2102x1736 — 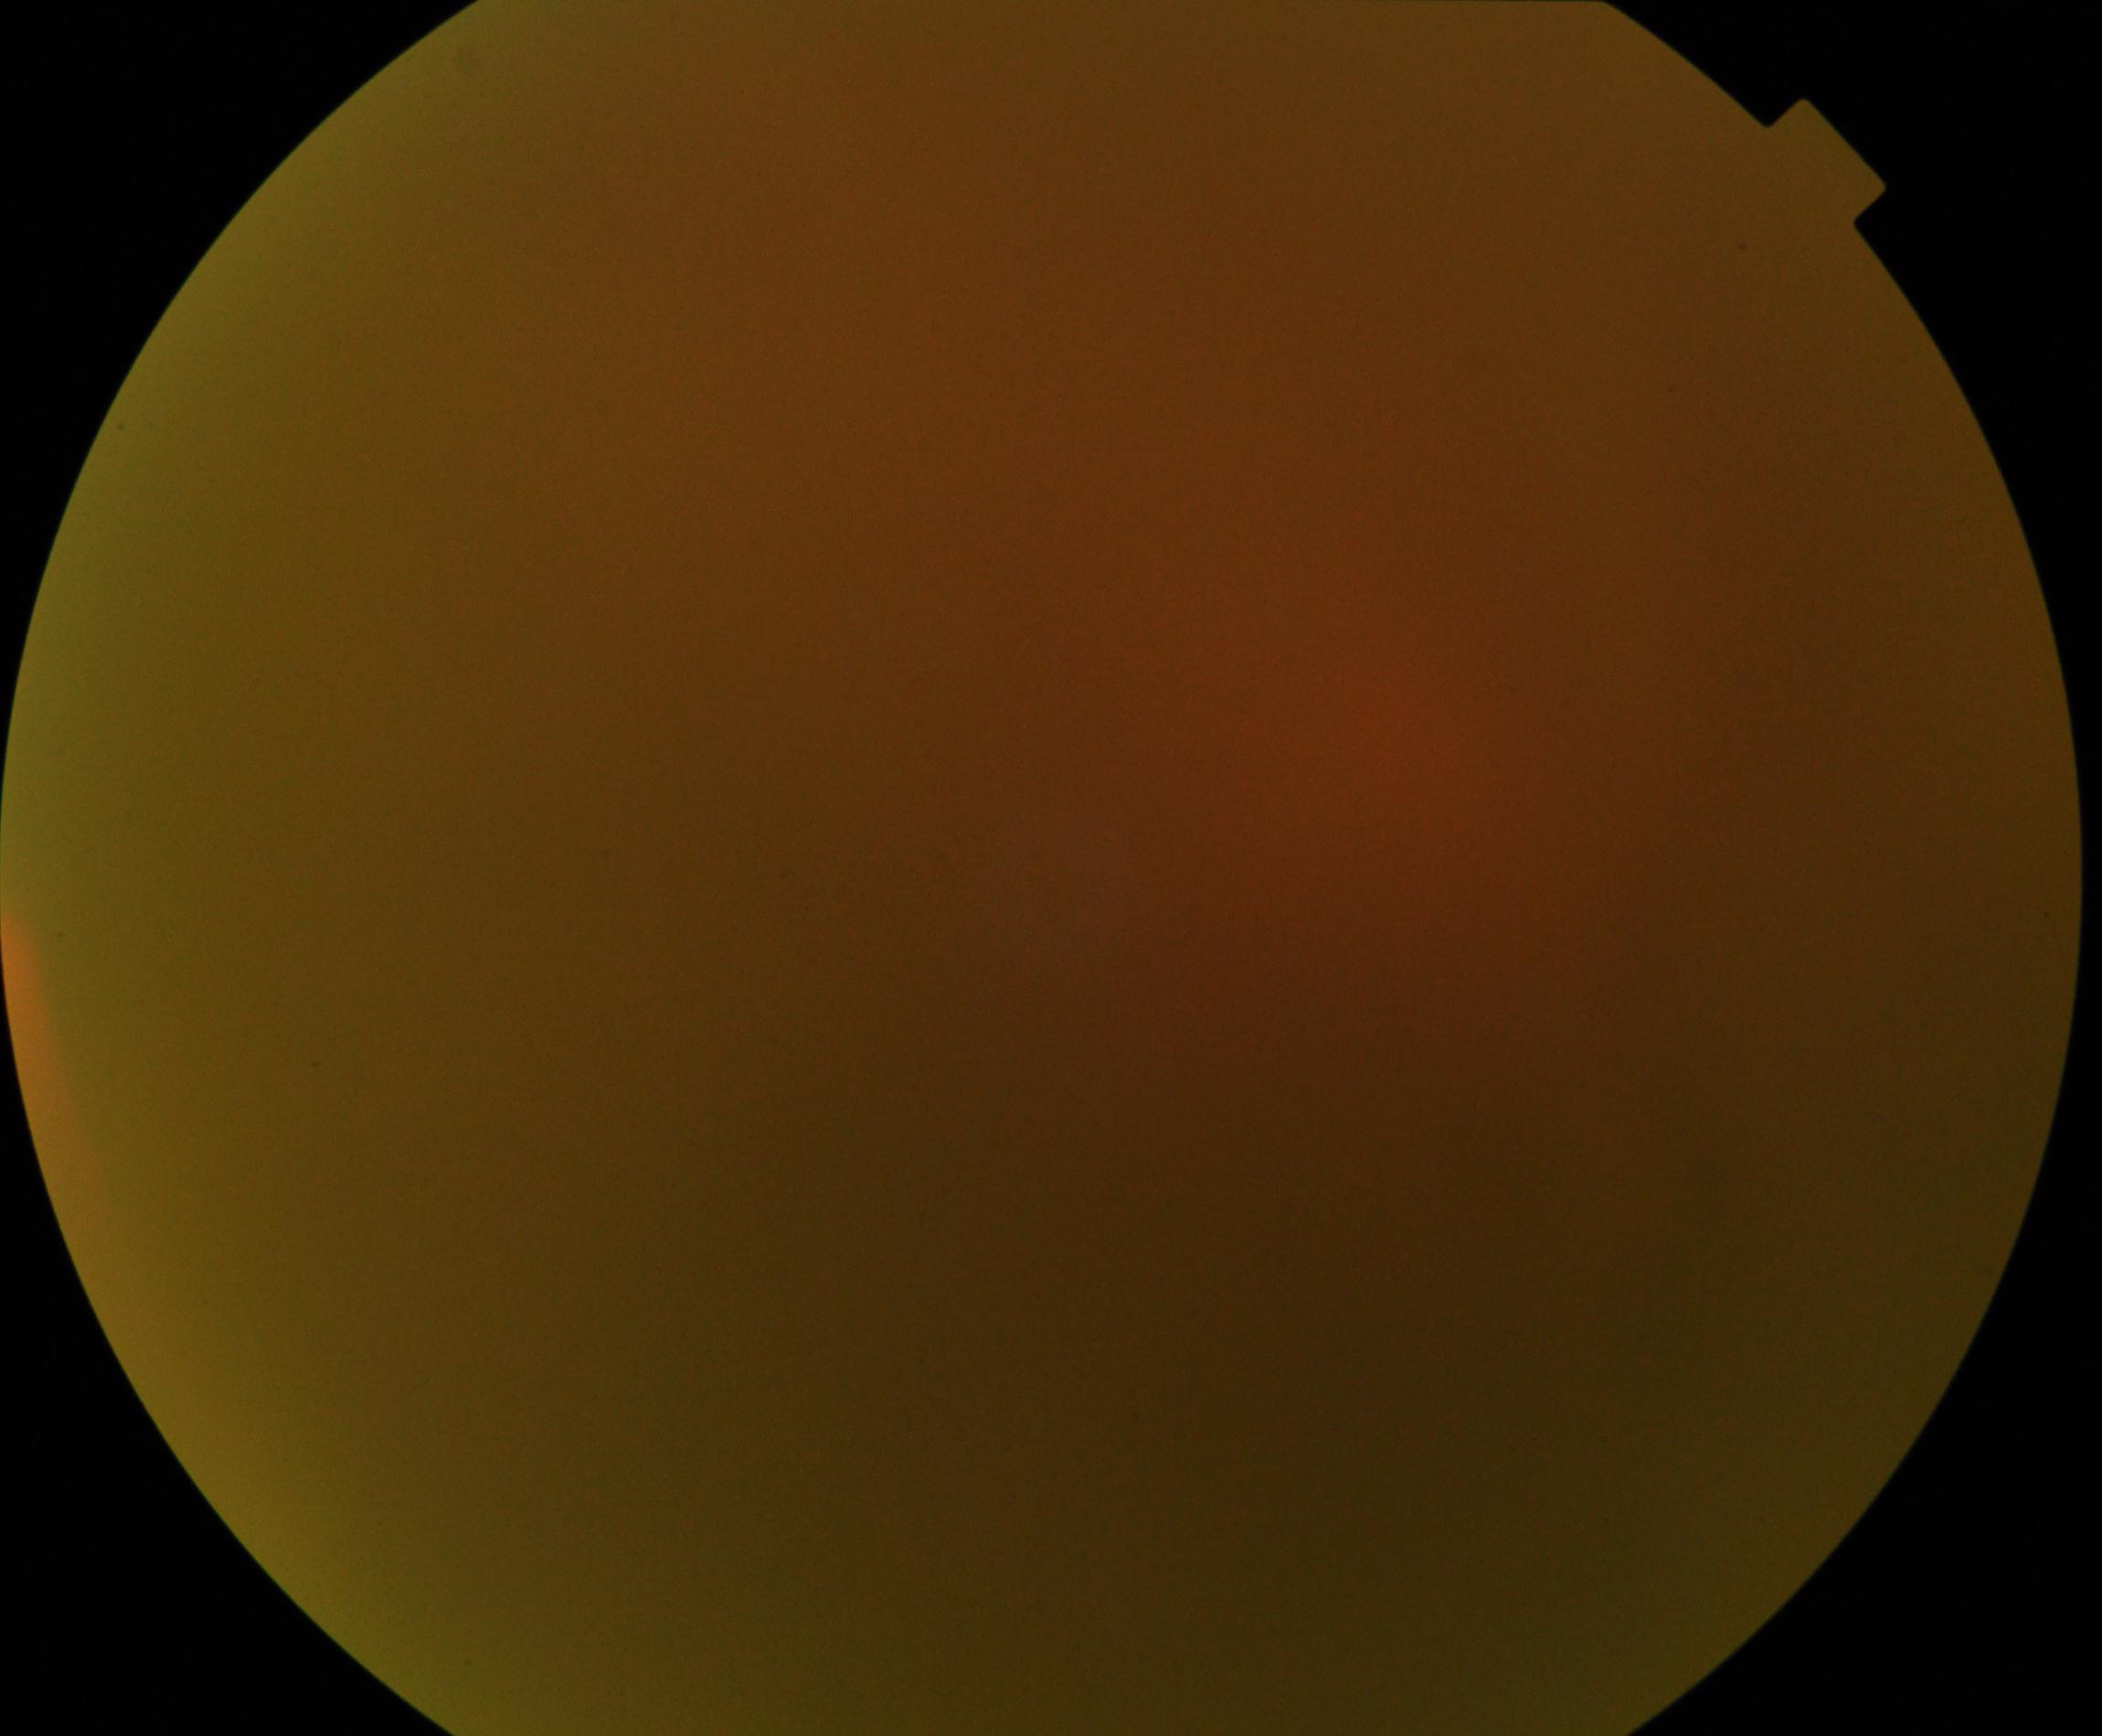
Image is blurred; retinal landmarks are largely obscured. No proliferative diabetic retinopathy identified.